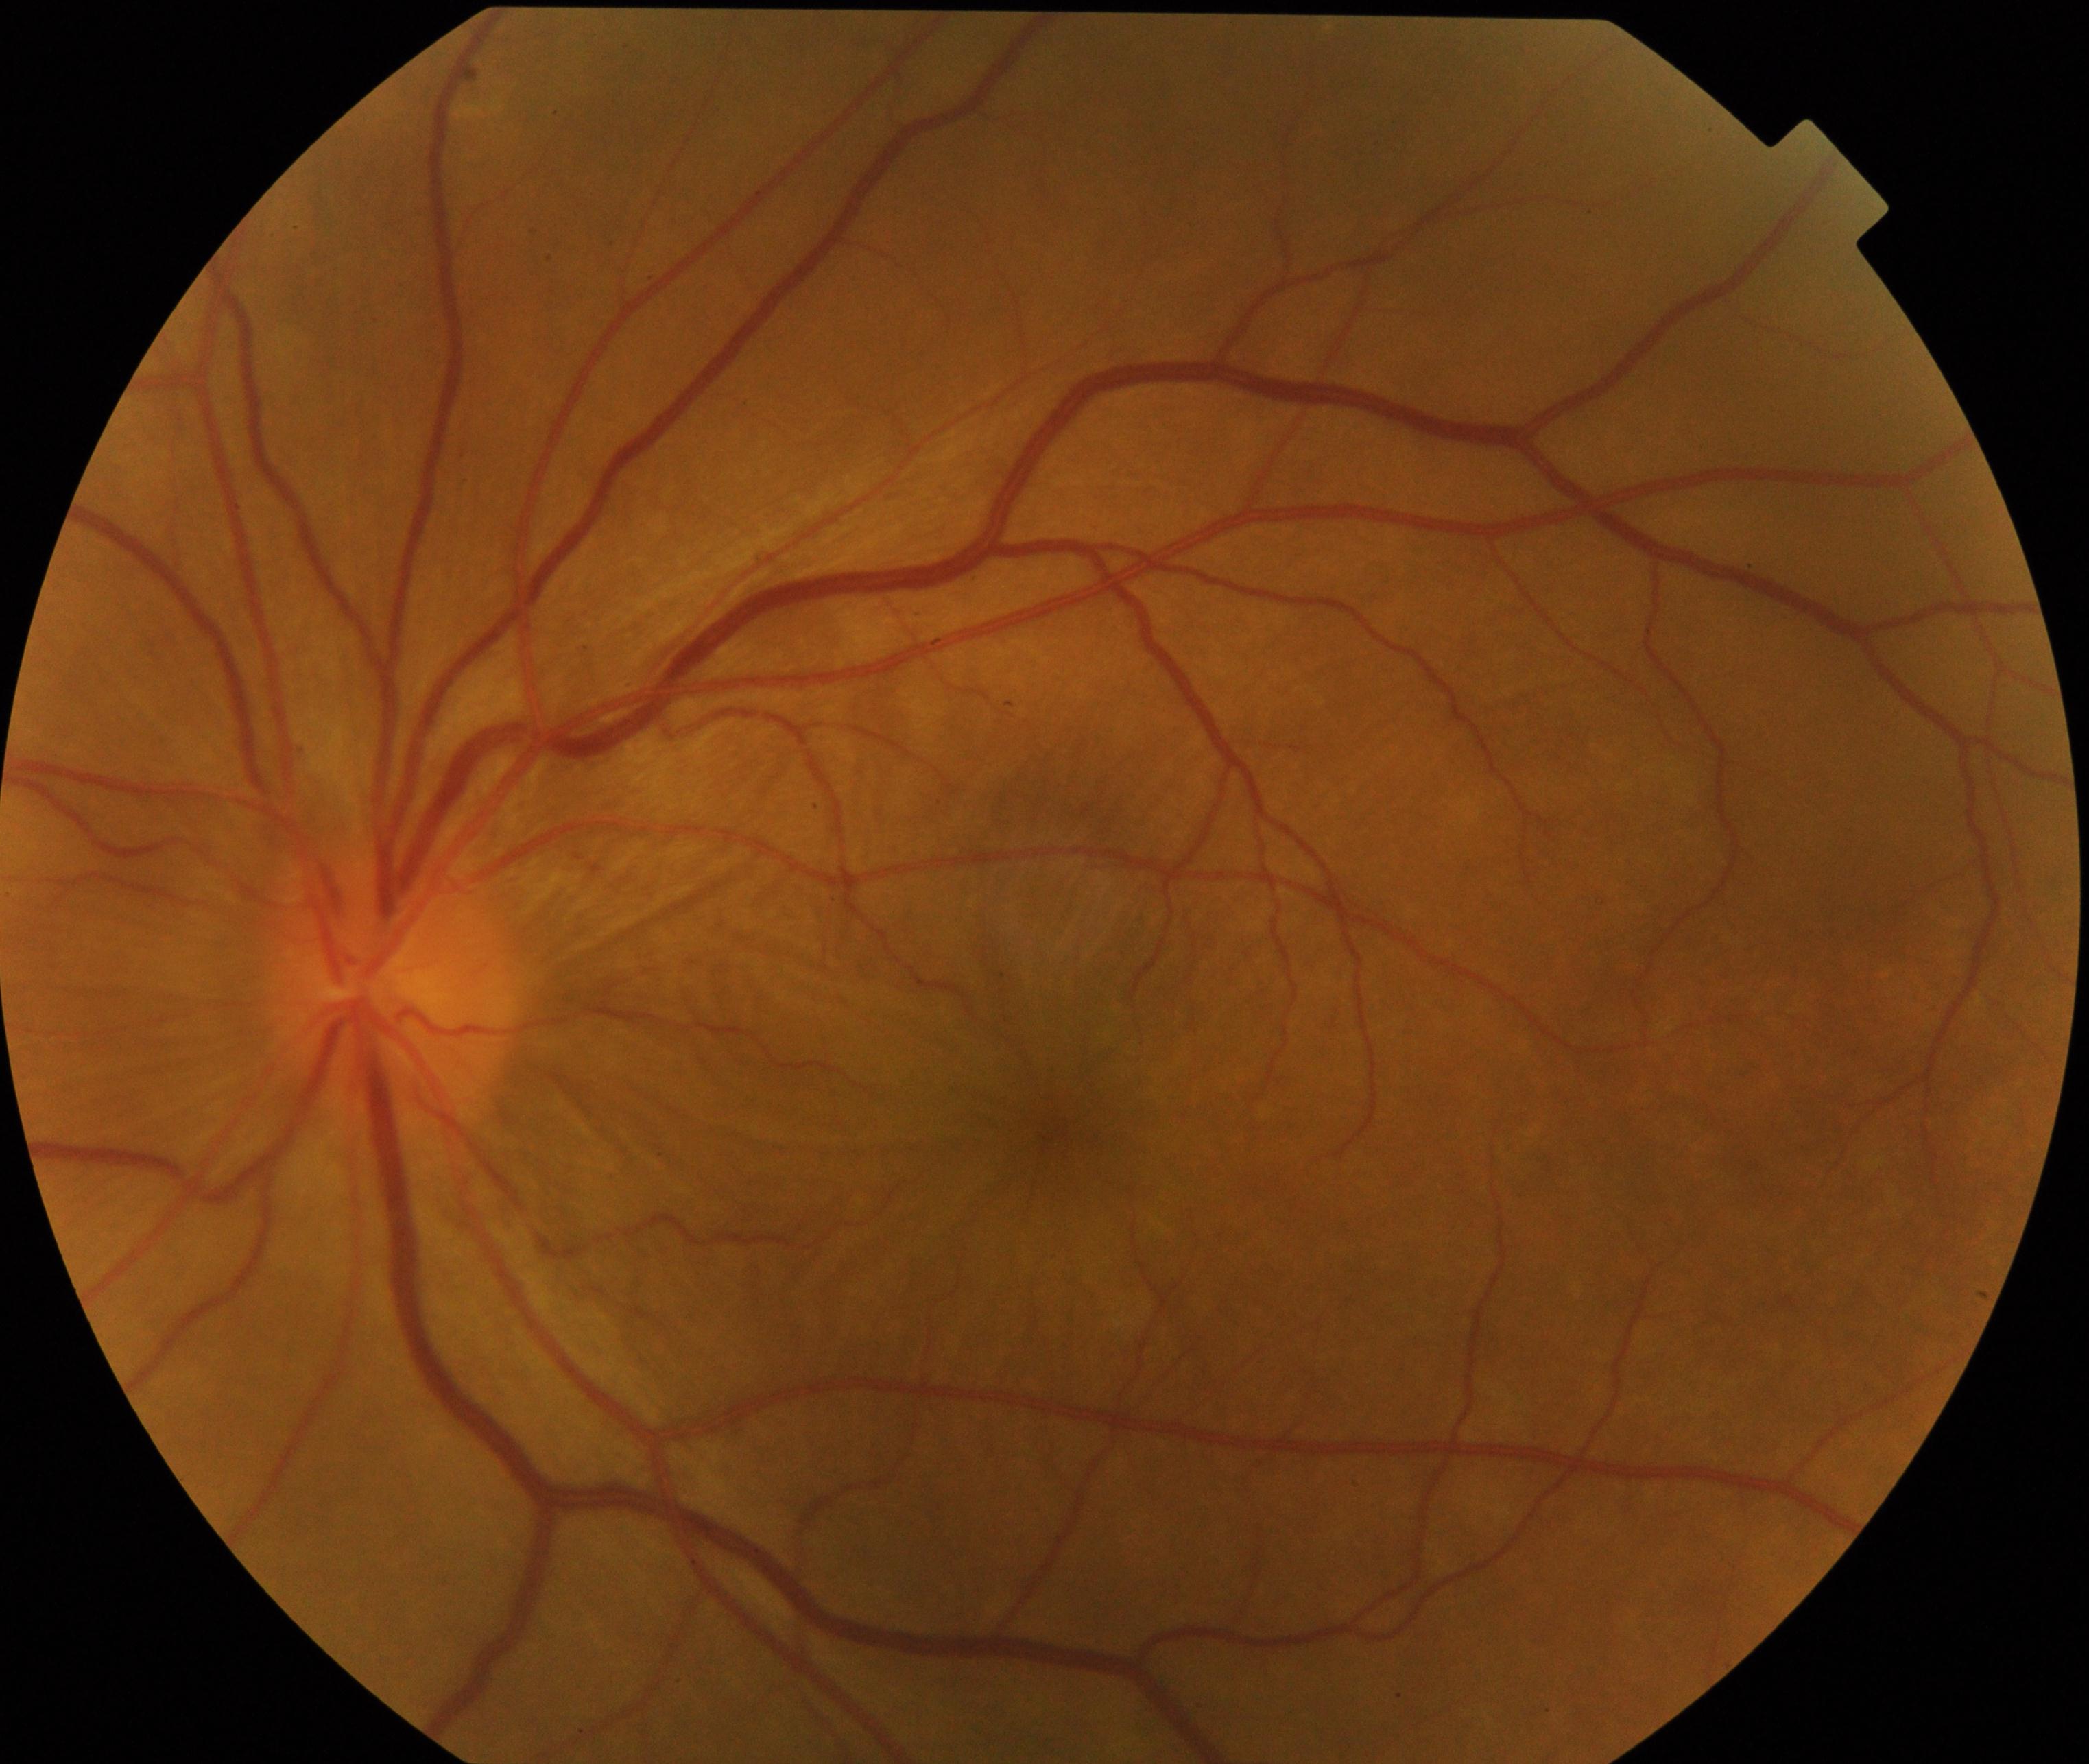 Impression: Vogt-Koyanagi-Harada disease. Features include circumscribed retinal edema with multiple exudative retinal detachments of the posterior retina, often with optic disc hyperemia and edema; an obscure retina with slight radial folds can be seen as the edema resolves.